Captured with the Natus RetCam Envision (130° field of view). Pediatric wide-field fundus photograph. 1440 by 1080 pixels
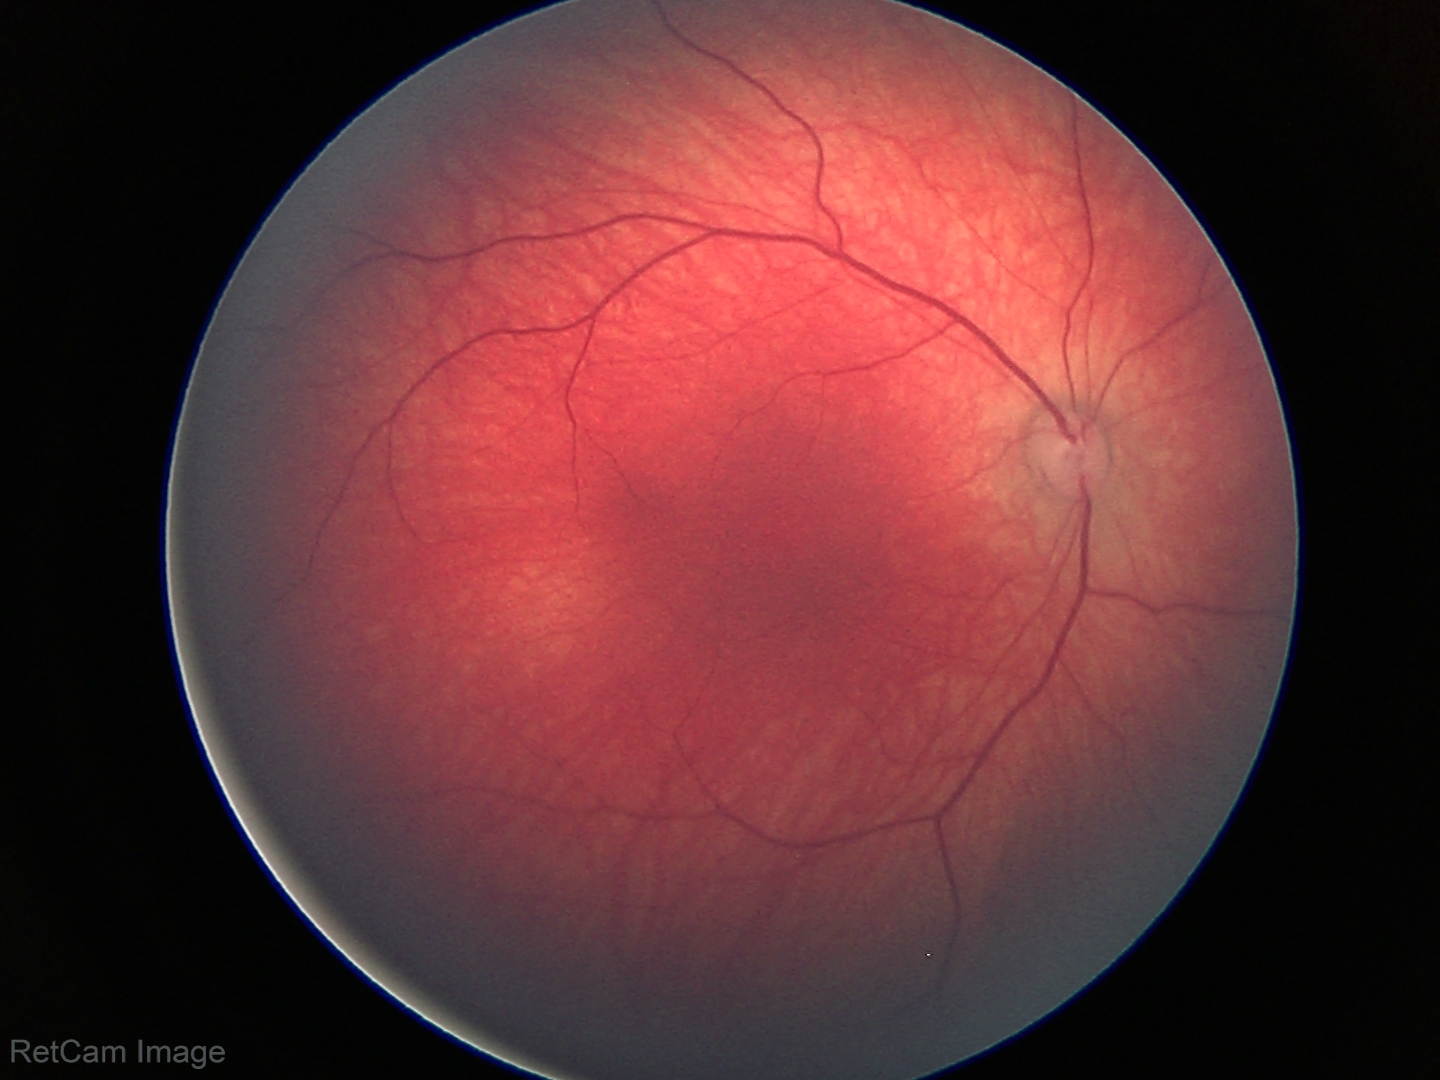

No retinal pathology identified on screening.